Color fundus photograph:
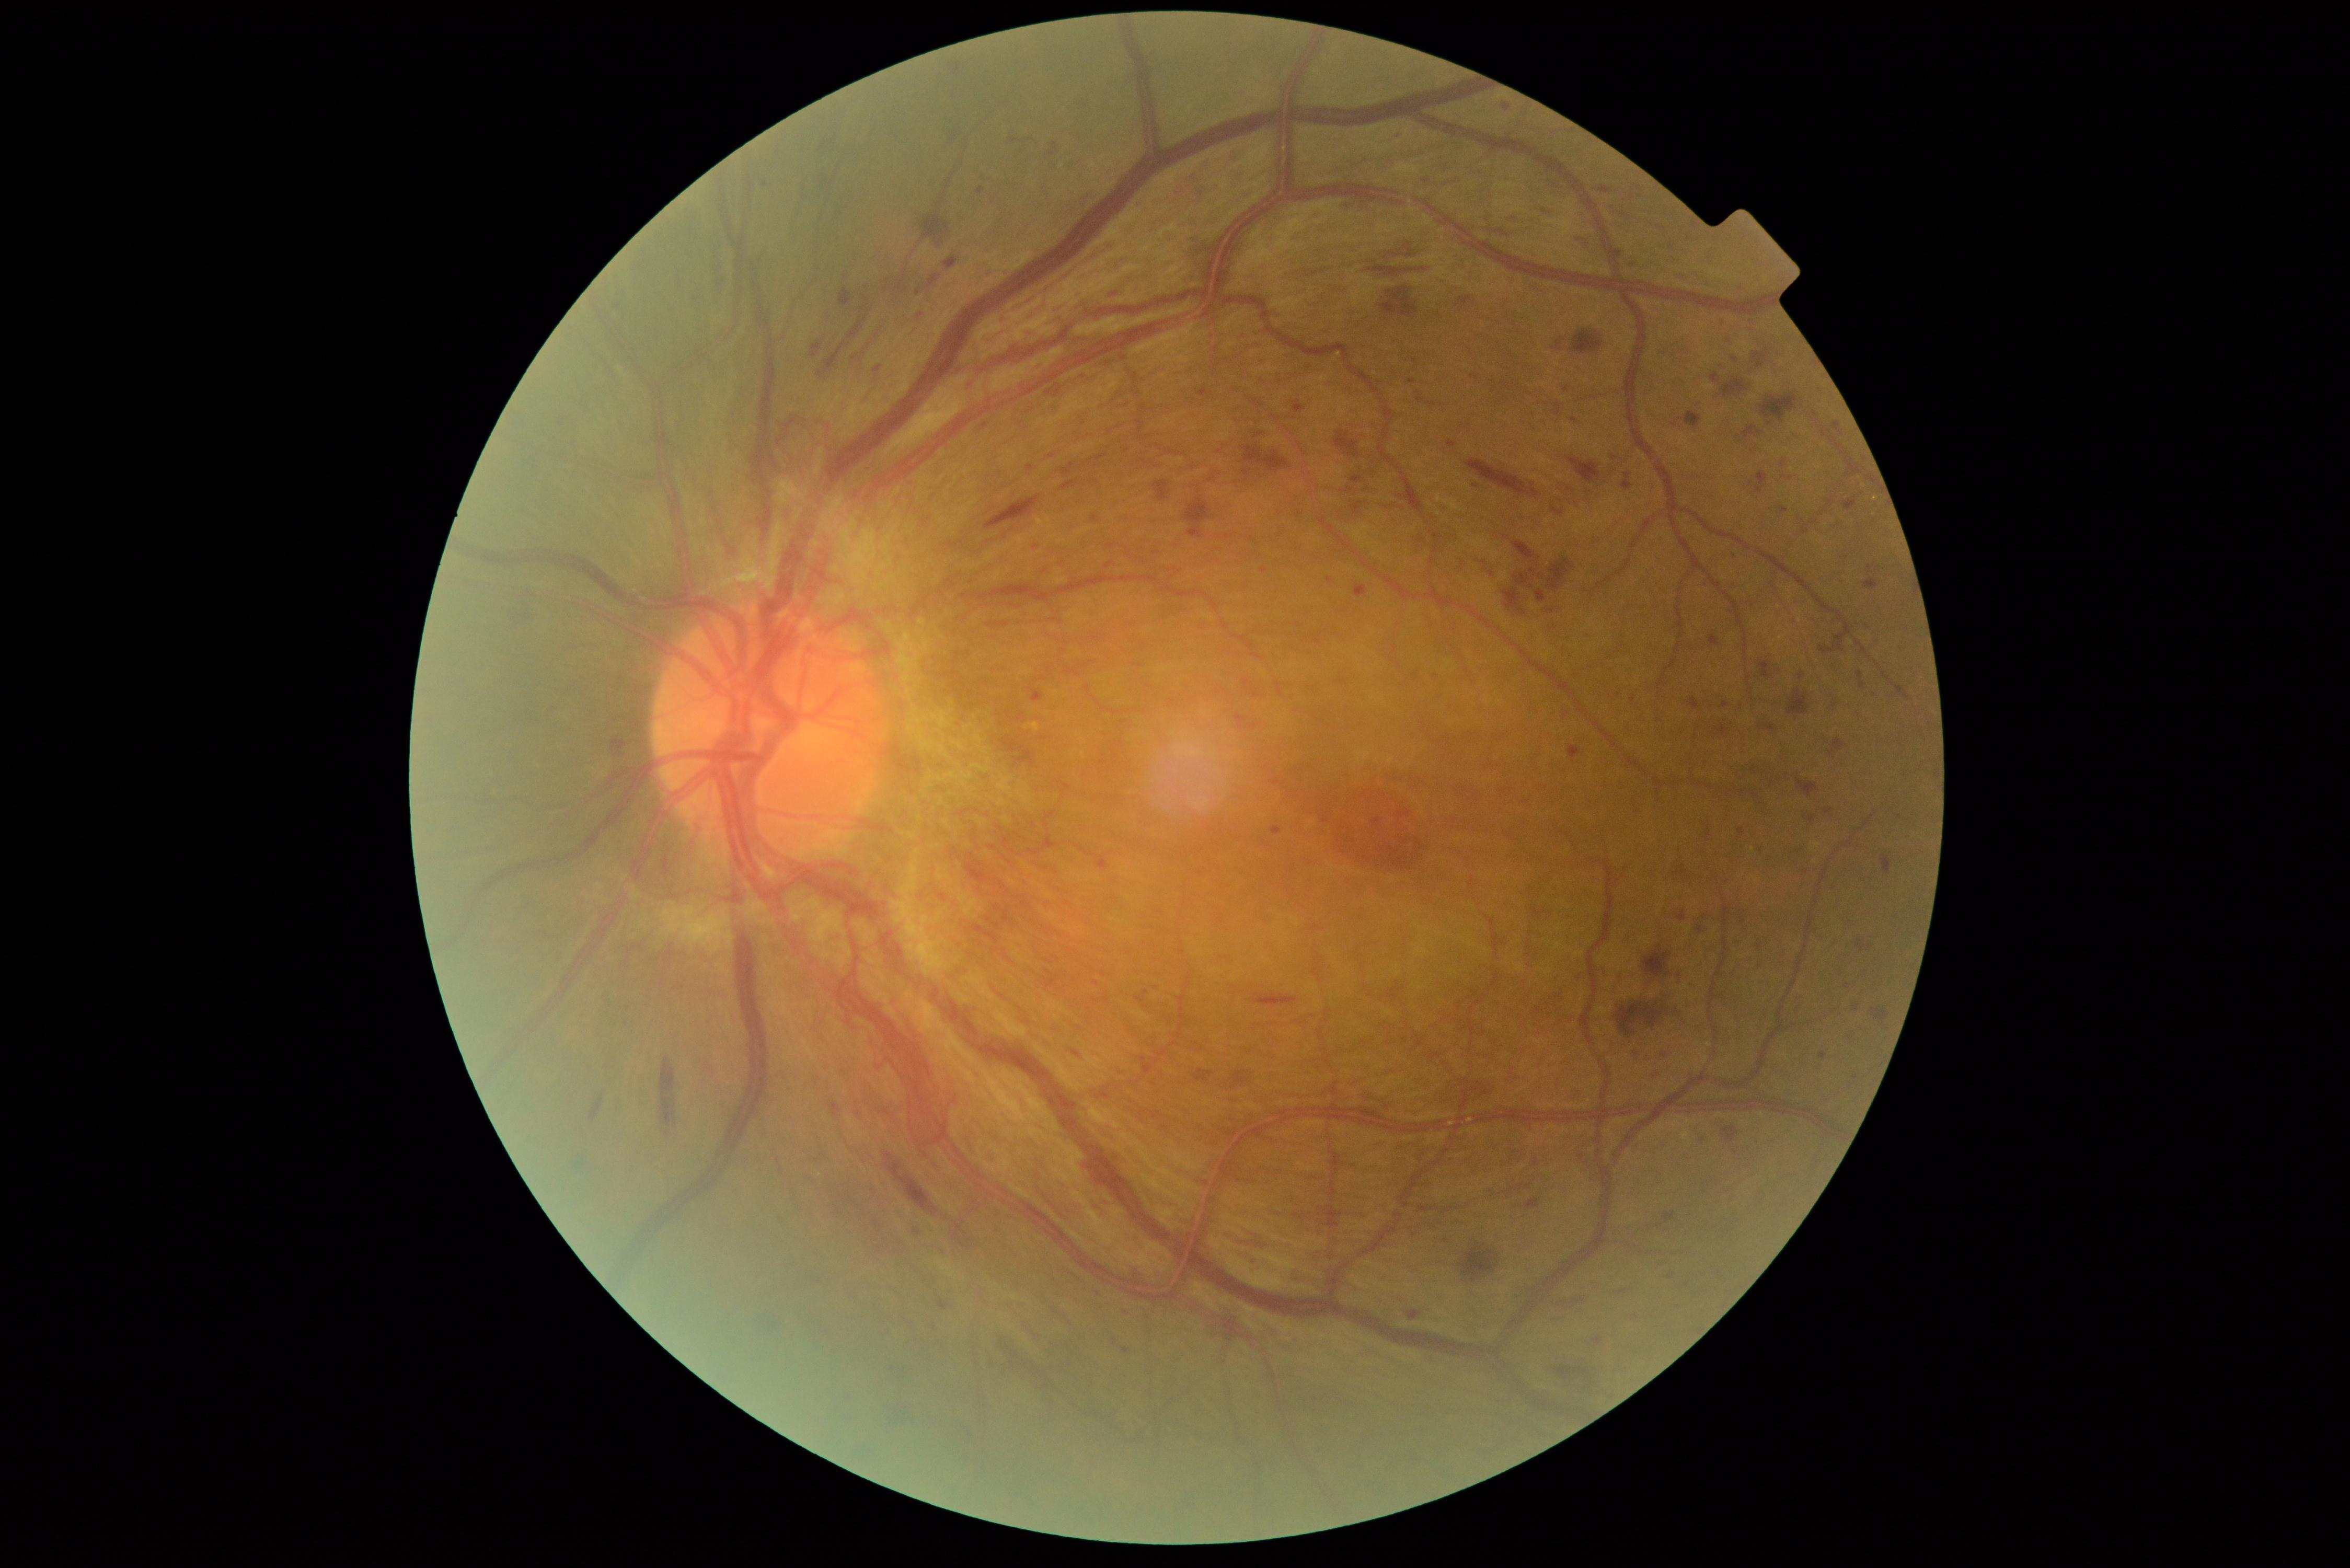

{"partial":true,"dr_grade":4,"lesions":{"ma":[[1398,810,1410,820],[1031,693,1042,702],[1857,672,1867,689],[1795,993,1804,1000],[1123,1348,1131,1354],[1447,441,1458,448],[1272,826,1282,835],[1701,1138,1706,1146],[1663,1053,1668,1062]],"ma_small":[[1476,487],[1614,458],[1575,421],[1252,1259],[1837,425],[1057,393],[1735,360],[1052,456]],"he":[[1368,266,1425,276],[1630,1048,1637,1057],[660,1057,677,1127],[1513,542,1537,562],[1881,855,1892,875],[1798,779,1818,798],[1647,1069,1664,1078],[1571,329,1603,355],[1062,463,1075,475],[1551,508,1563,516],[590,1098,604,1122],[1760,661,1770,679],[1664,1212,1675,1224],[1030,688,1044,703],[1706,829,1710,838],[839,289,853,307],[1577,238,1593,247],[999,1332,1028,1380],[886,1154,938,1215],[1795,672,1805,680]]}}